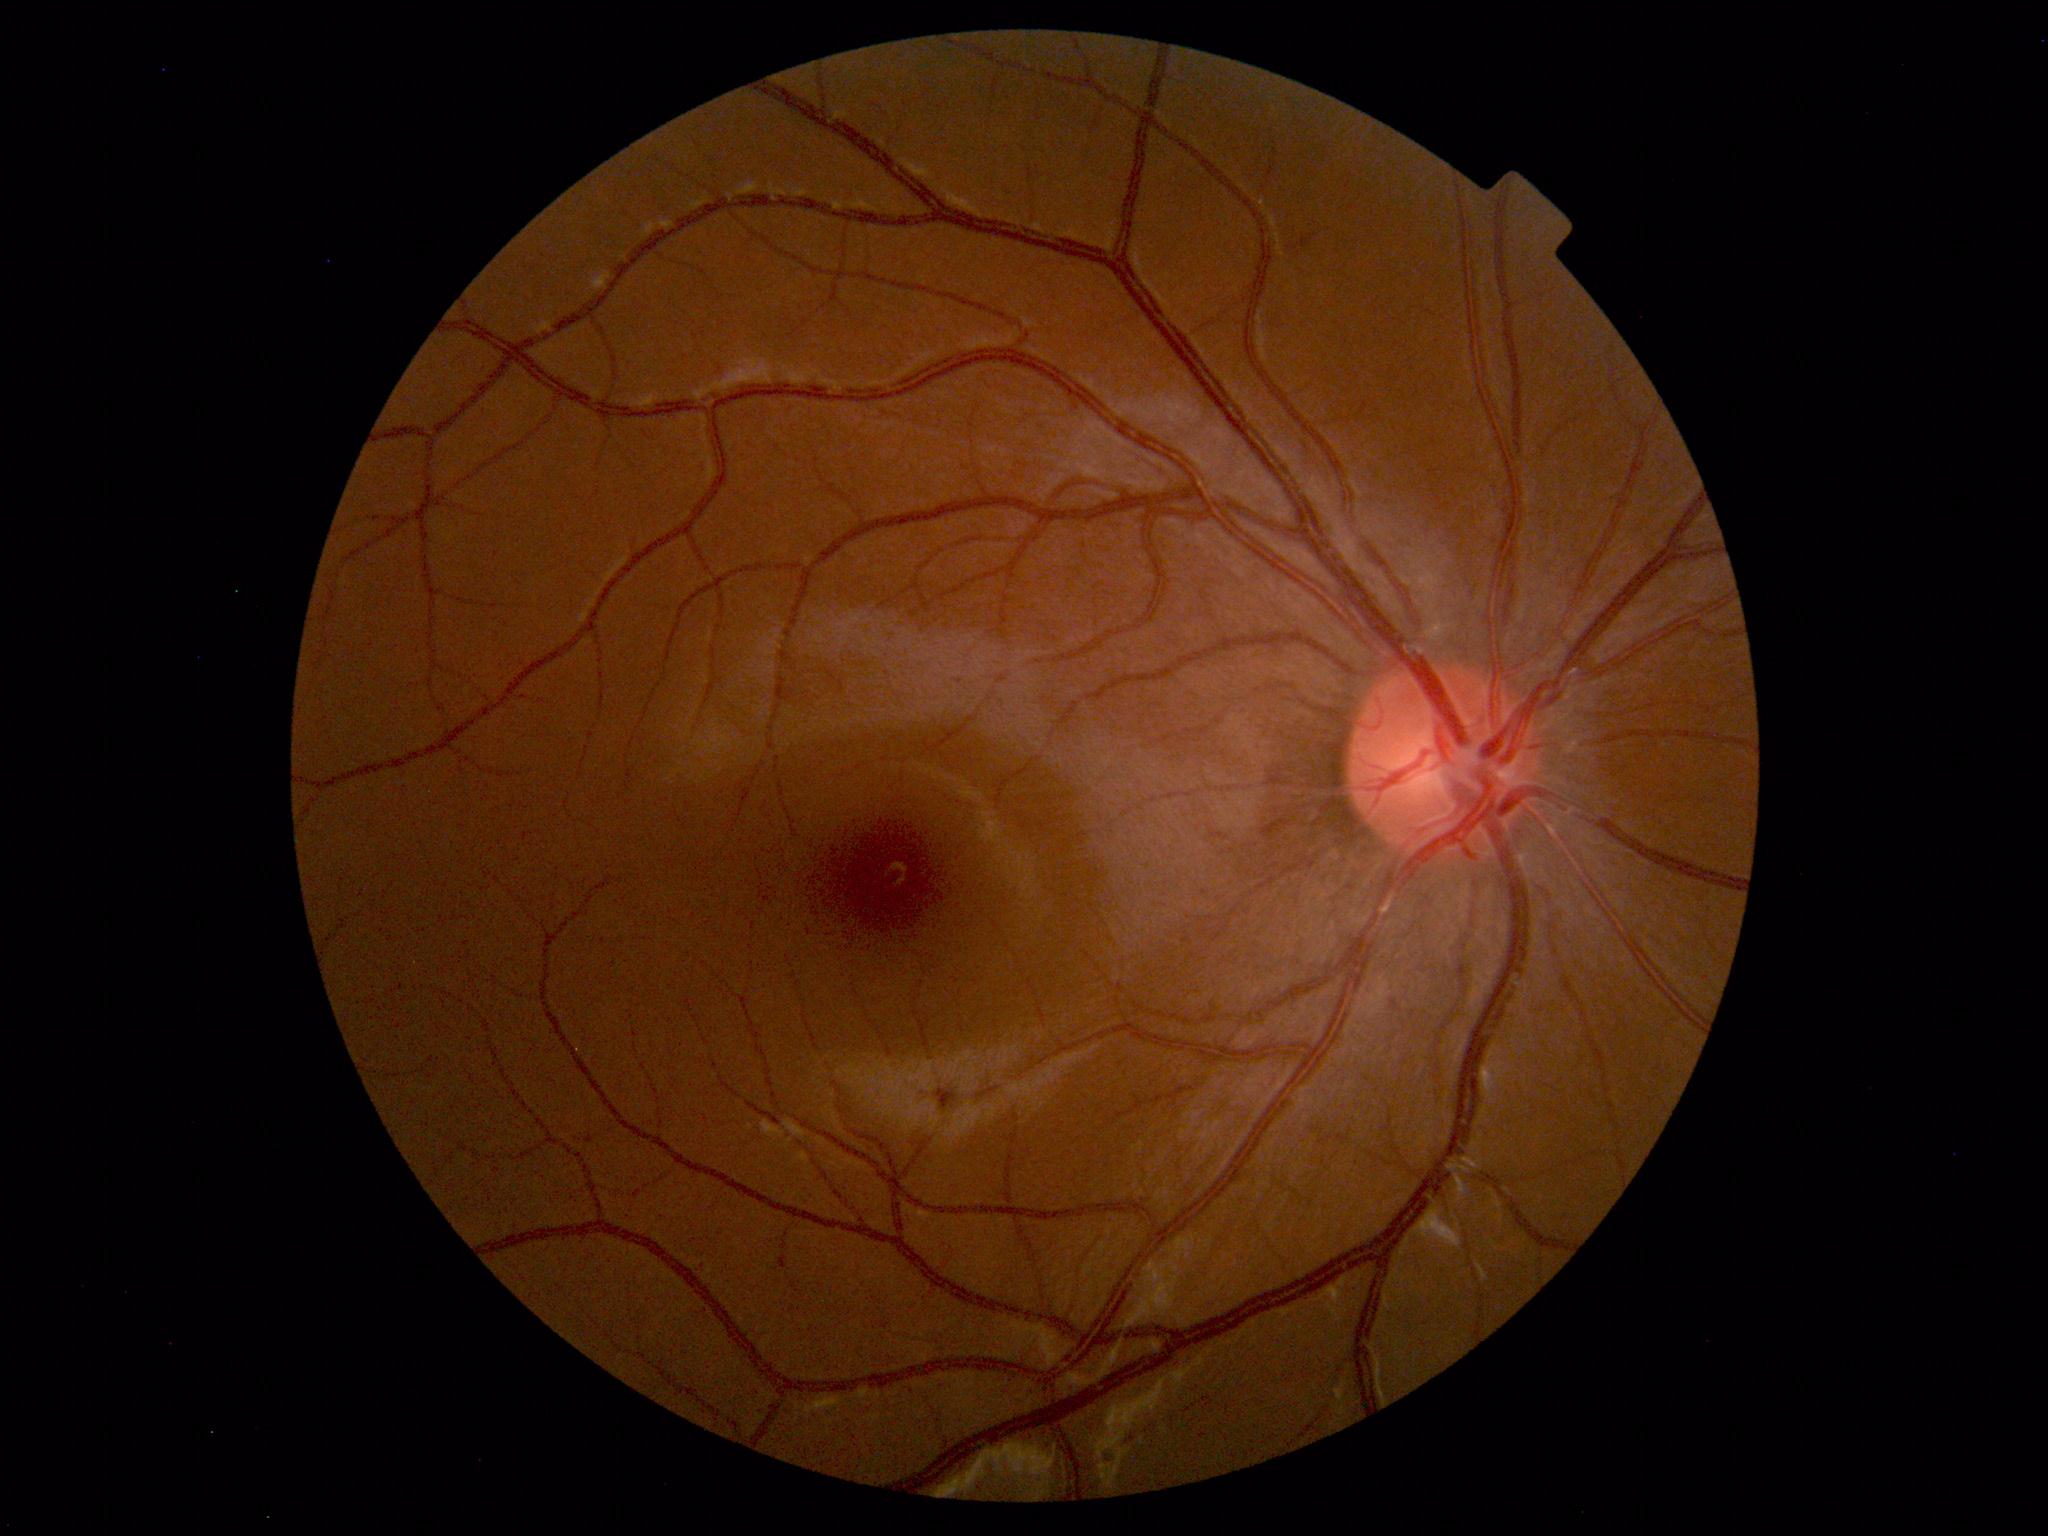 No retinal pathology identified.